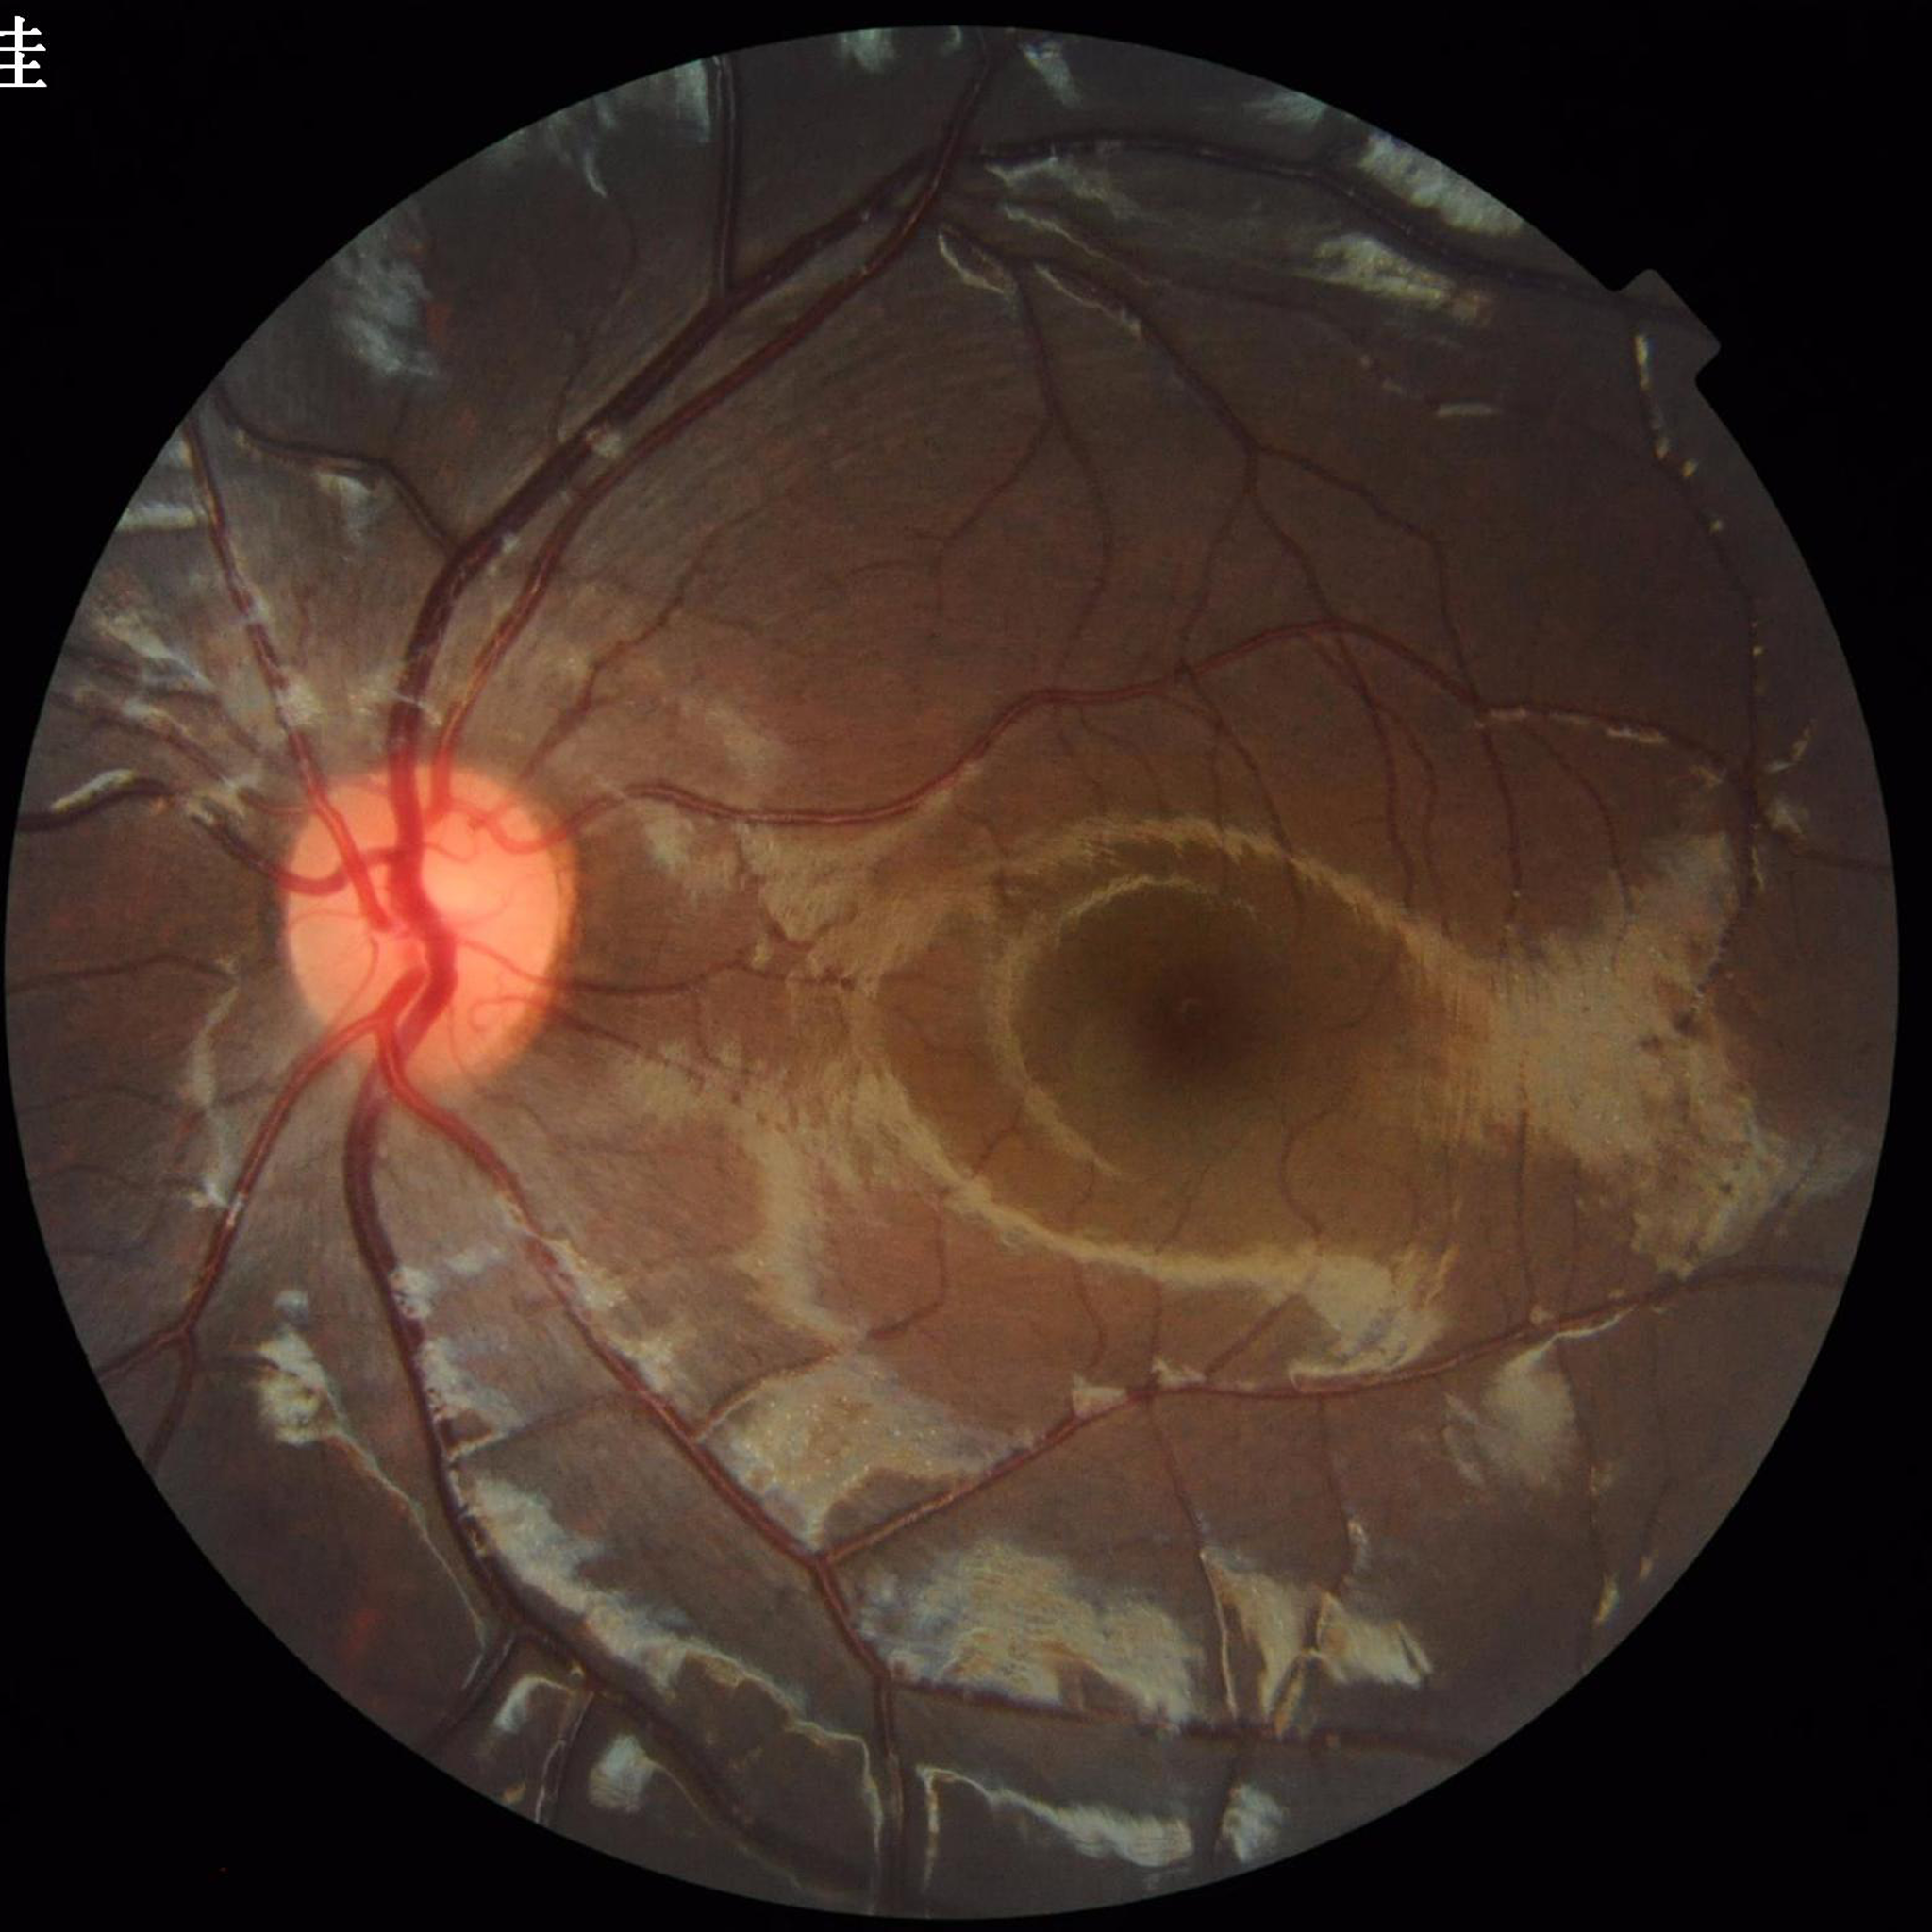 Automated quality assessment = good; Condition = no AMD, diabetic retinopathy, or glaucoma.